2184x1691, 45° field of view: 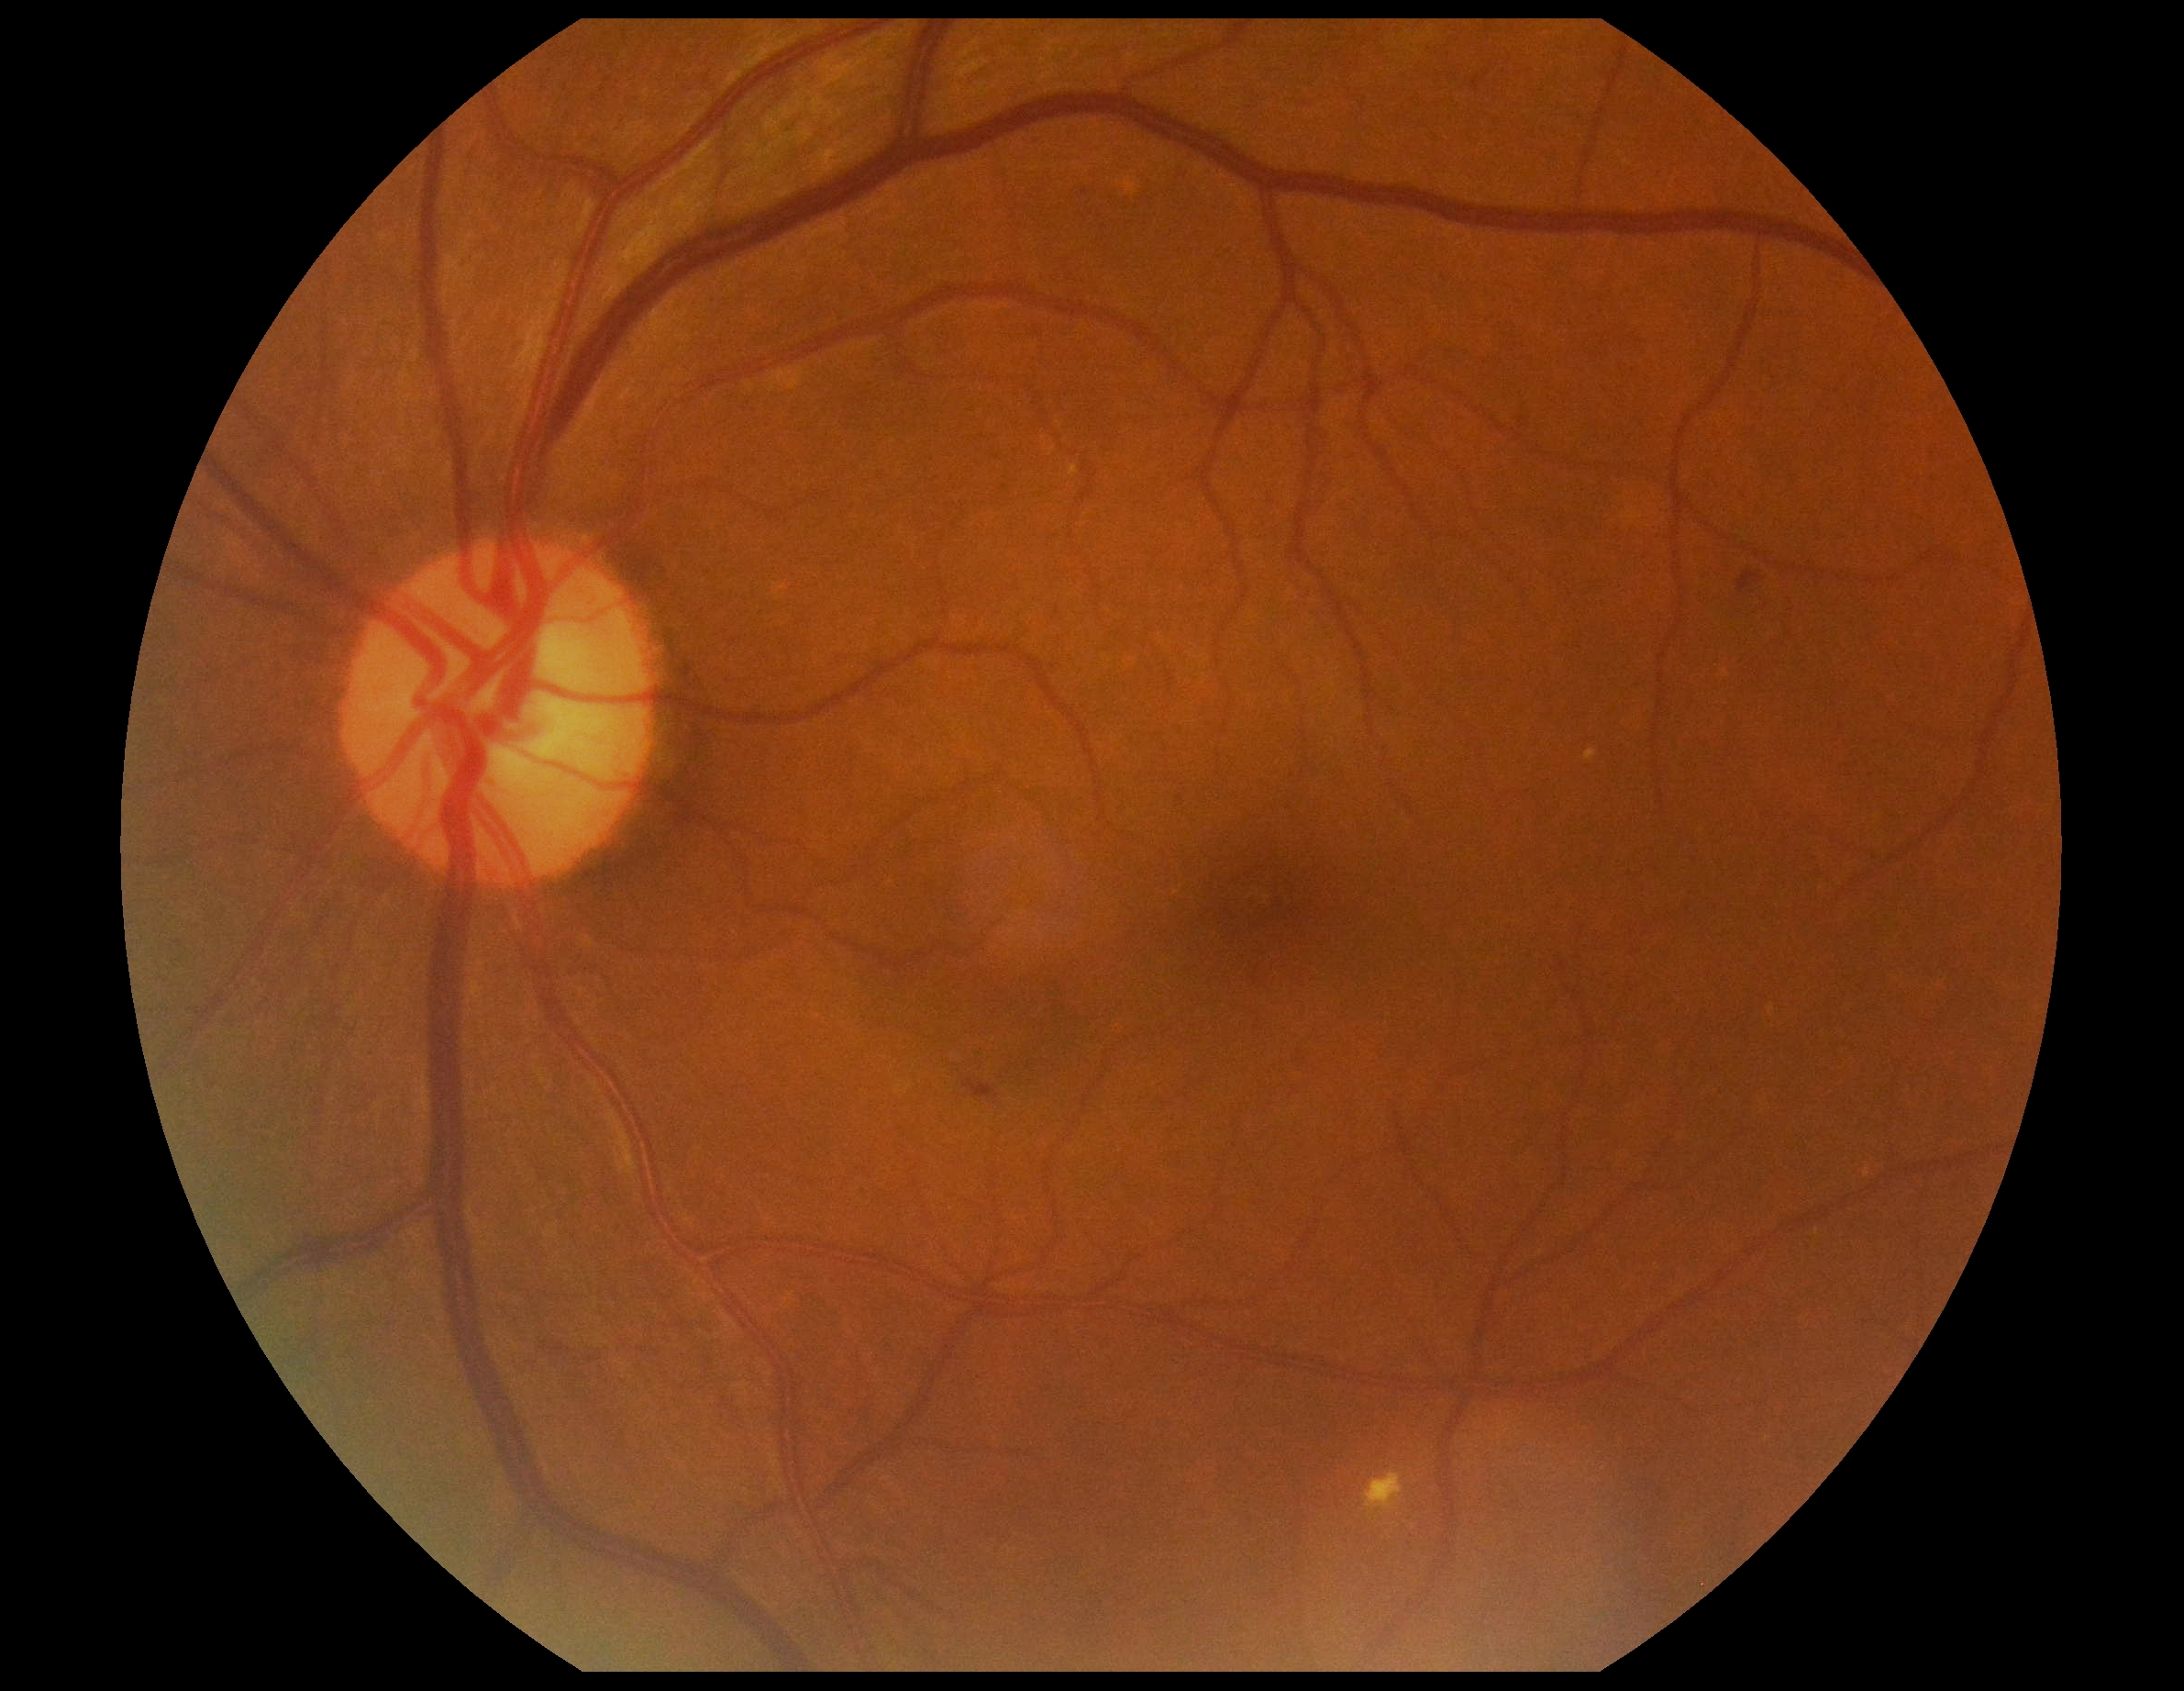
DR stage@2/4.